Posterior pole photograph. Image size 848x848. No pharmacologic dilation. 45 degree fundus photograph
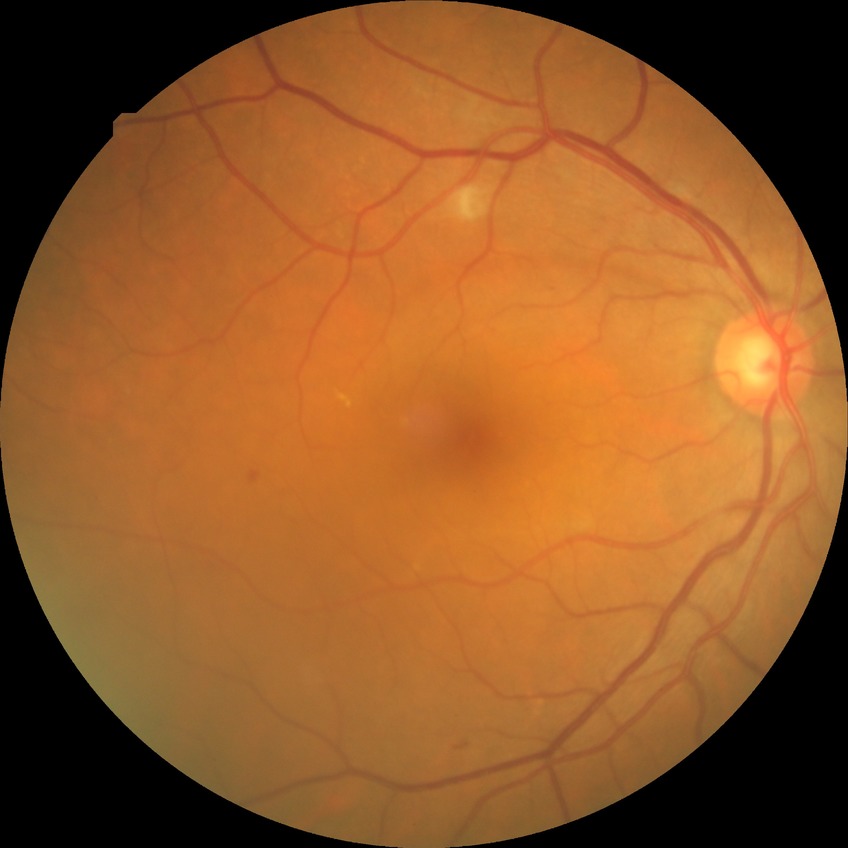 {
  "davis_grade": "pre-proliferative diabetic retinopathy (PPDR)"
}